Color fundus photograph · 1659 by 2212 pixels:
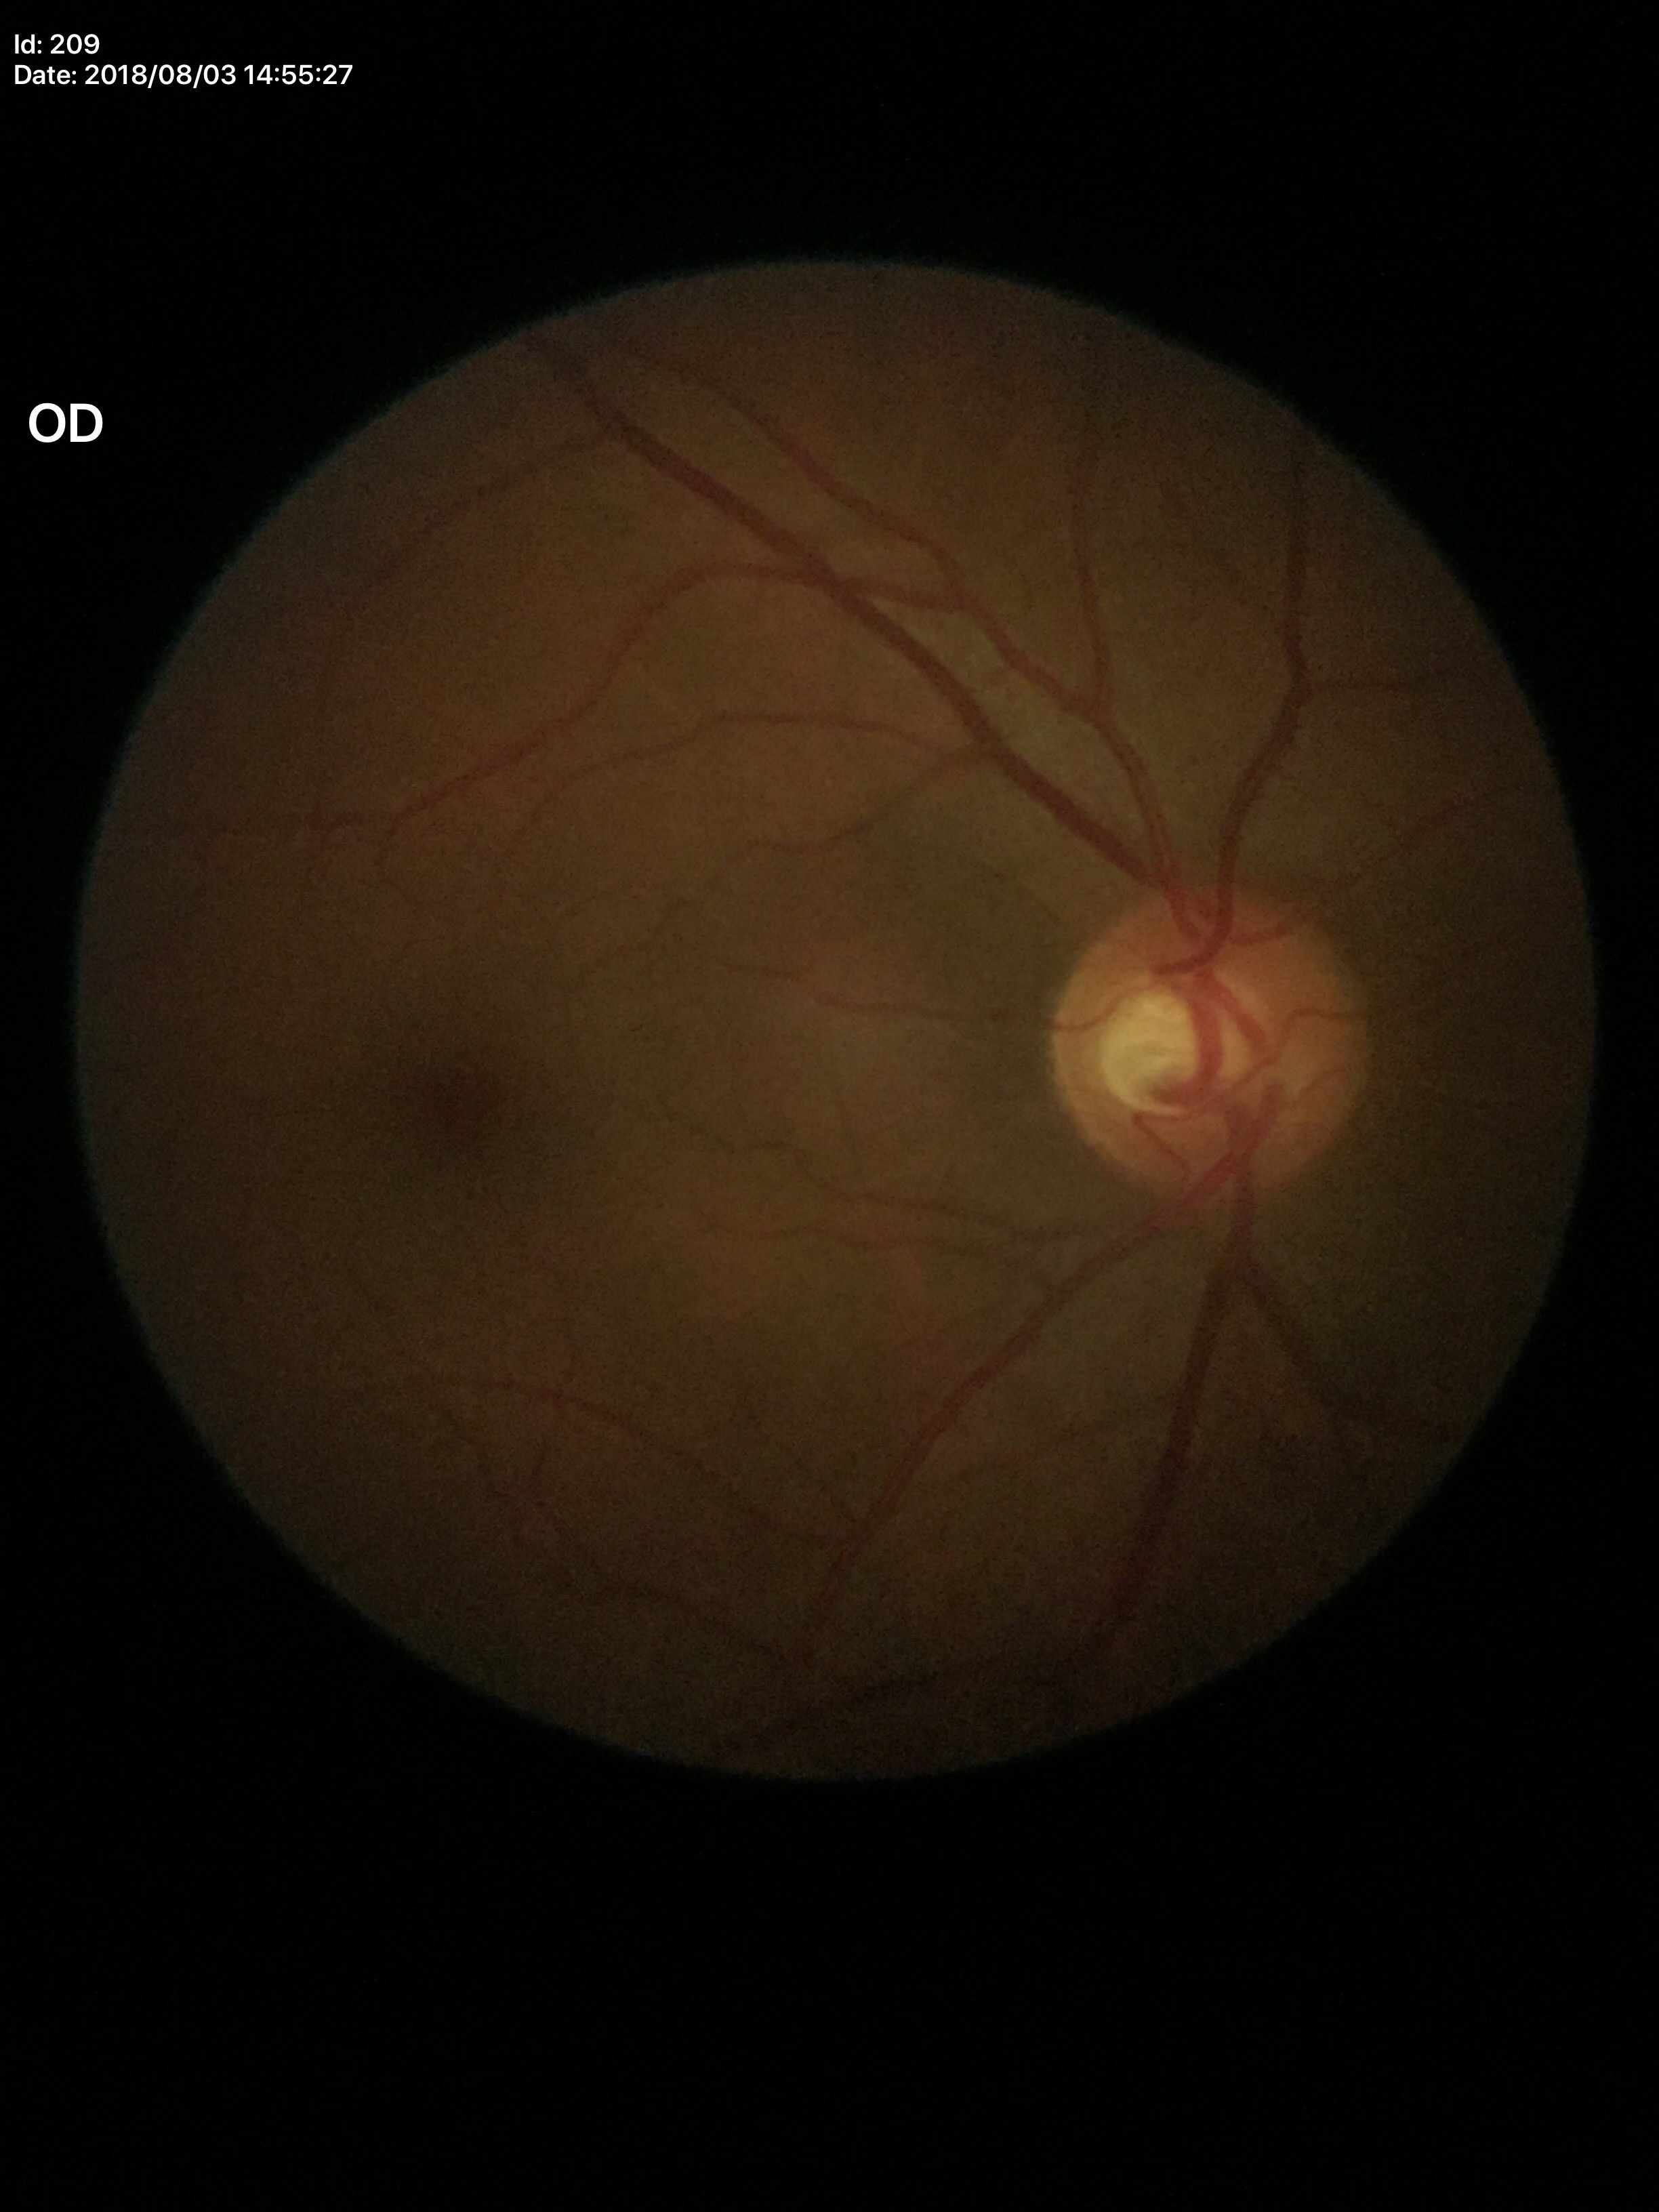

HCDR of 0.58. Glaucoma decision: no suspicious findings. ACDR is 0.30. VCDR: 0.51.